Camera: NIDEK AFC-230. 848 by 848 pixels:
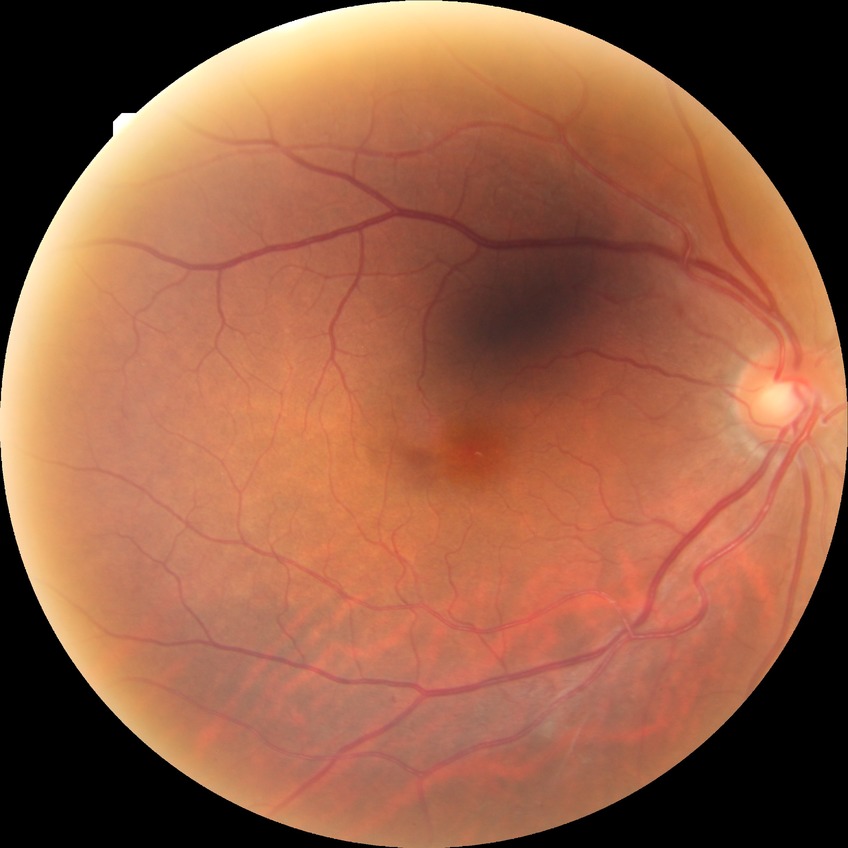

Diabetic retinopathy (DR) is SDR (simple diabetic retinopathy).